Without pupil dilation · image size 848x848 · NIDEK AFC-230 · 45° FOV:
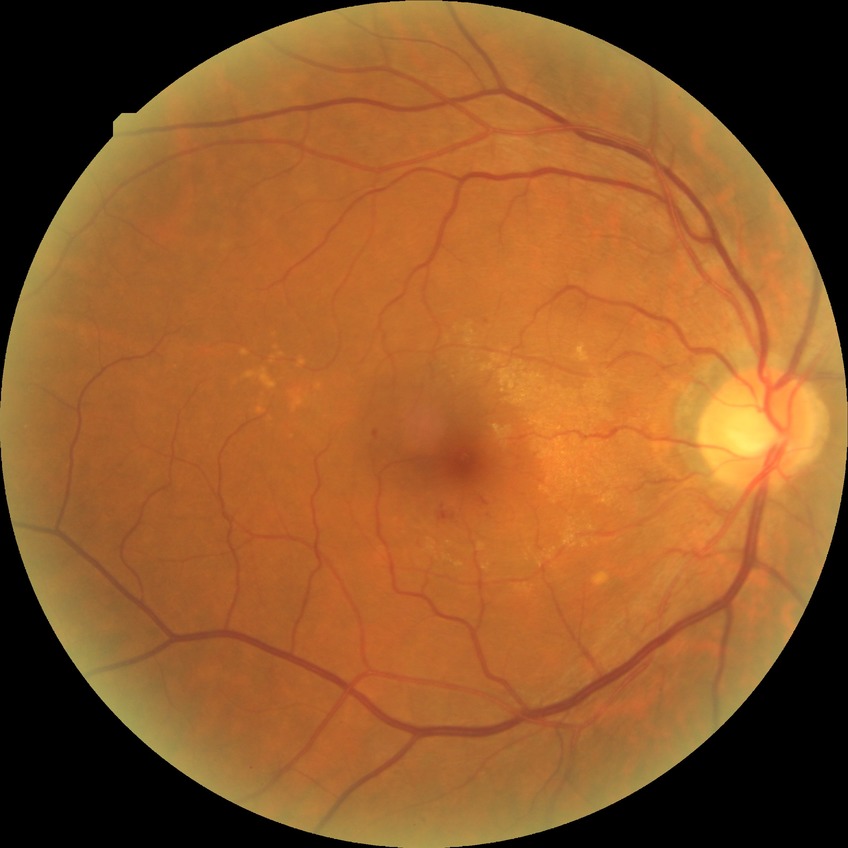
Findings:
– modified Davis classification — simple diabetic retinopathy